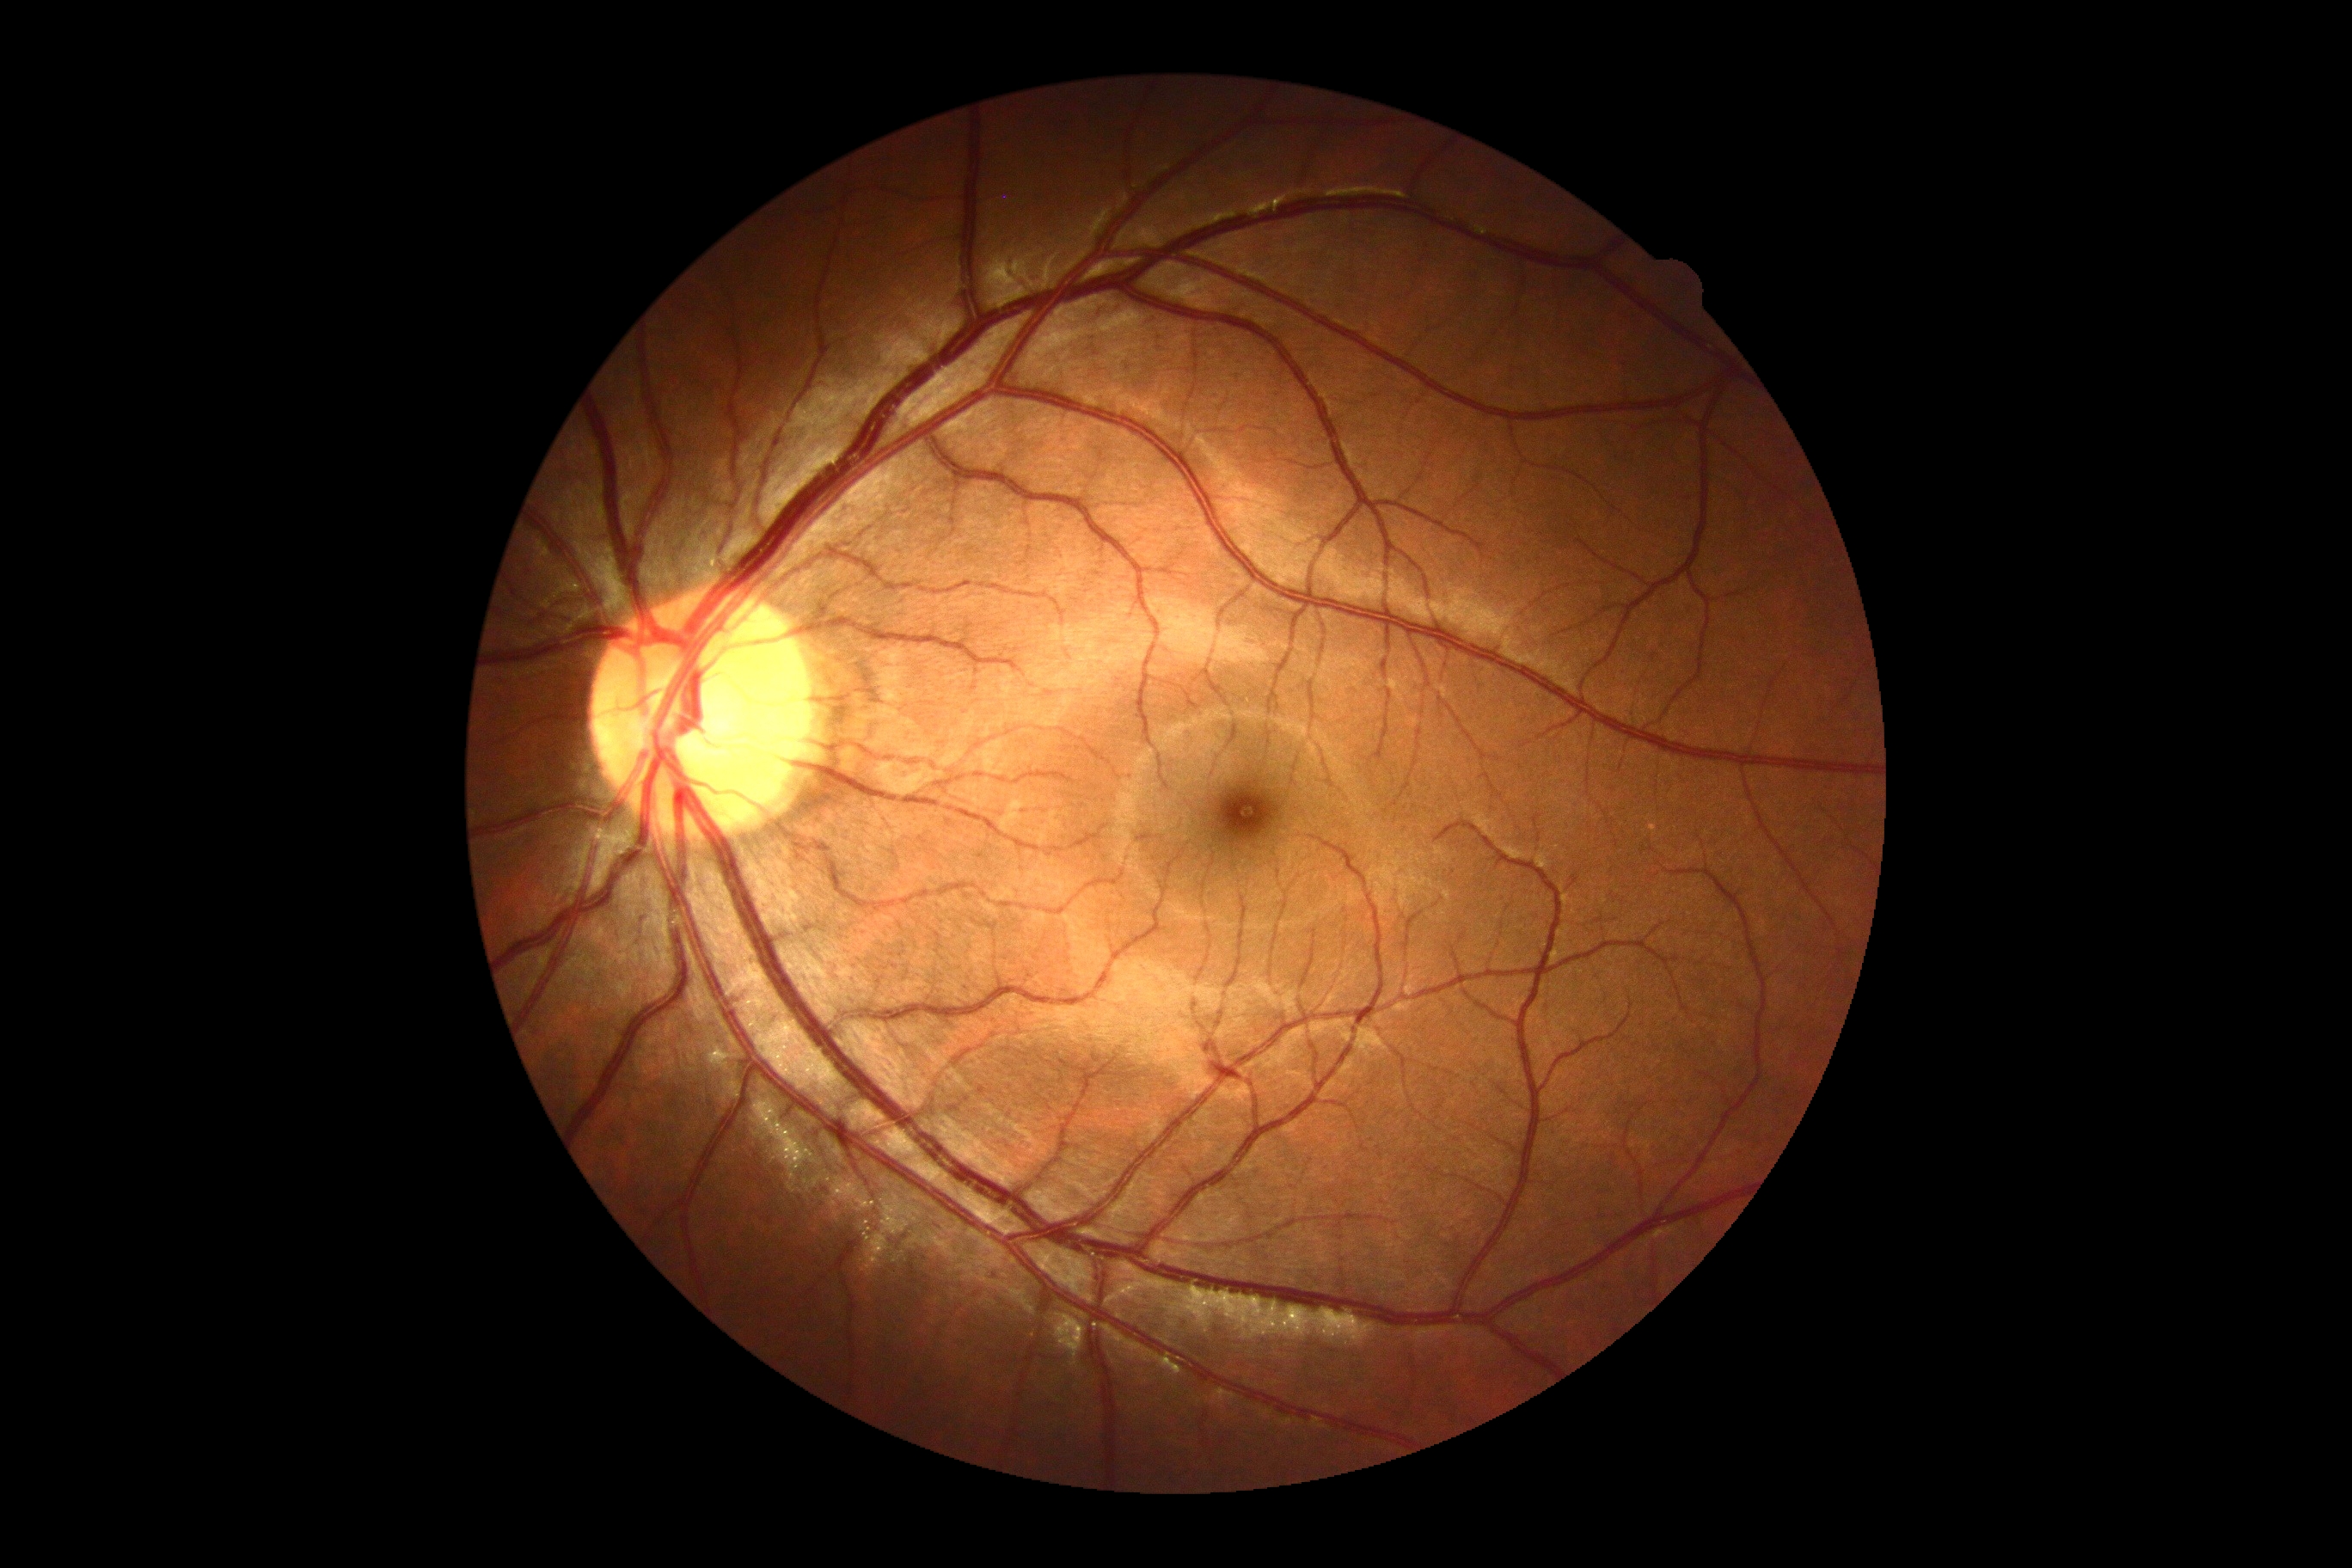 - retinopathy — 0/4 — no visible signs of diabetic retinopathy
- DR impression — no signs of DR